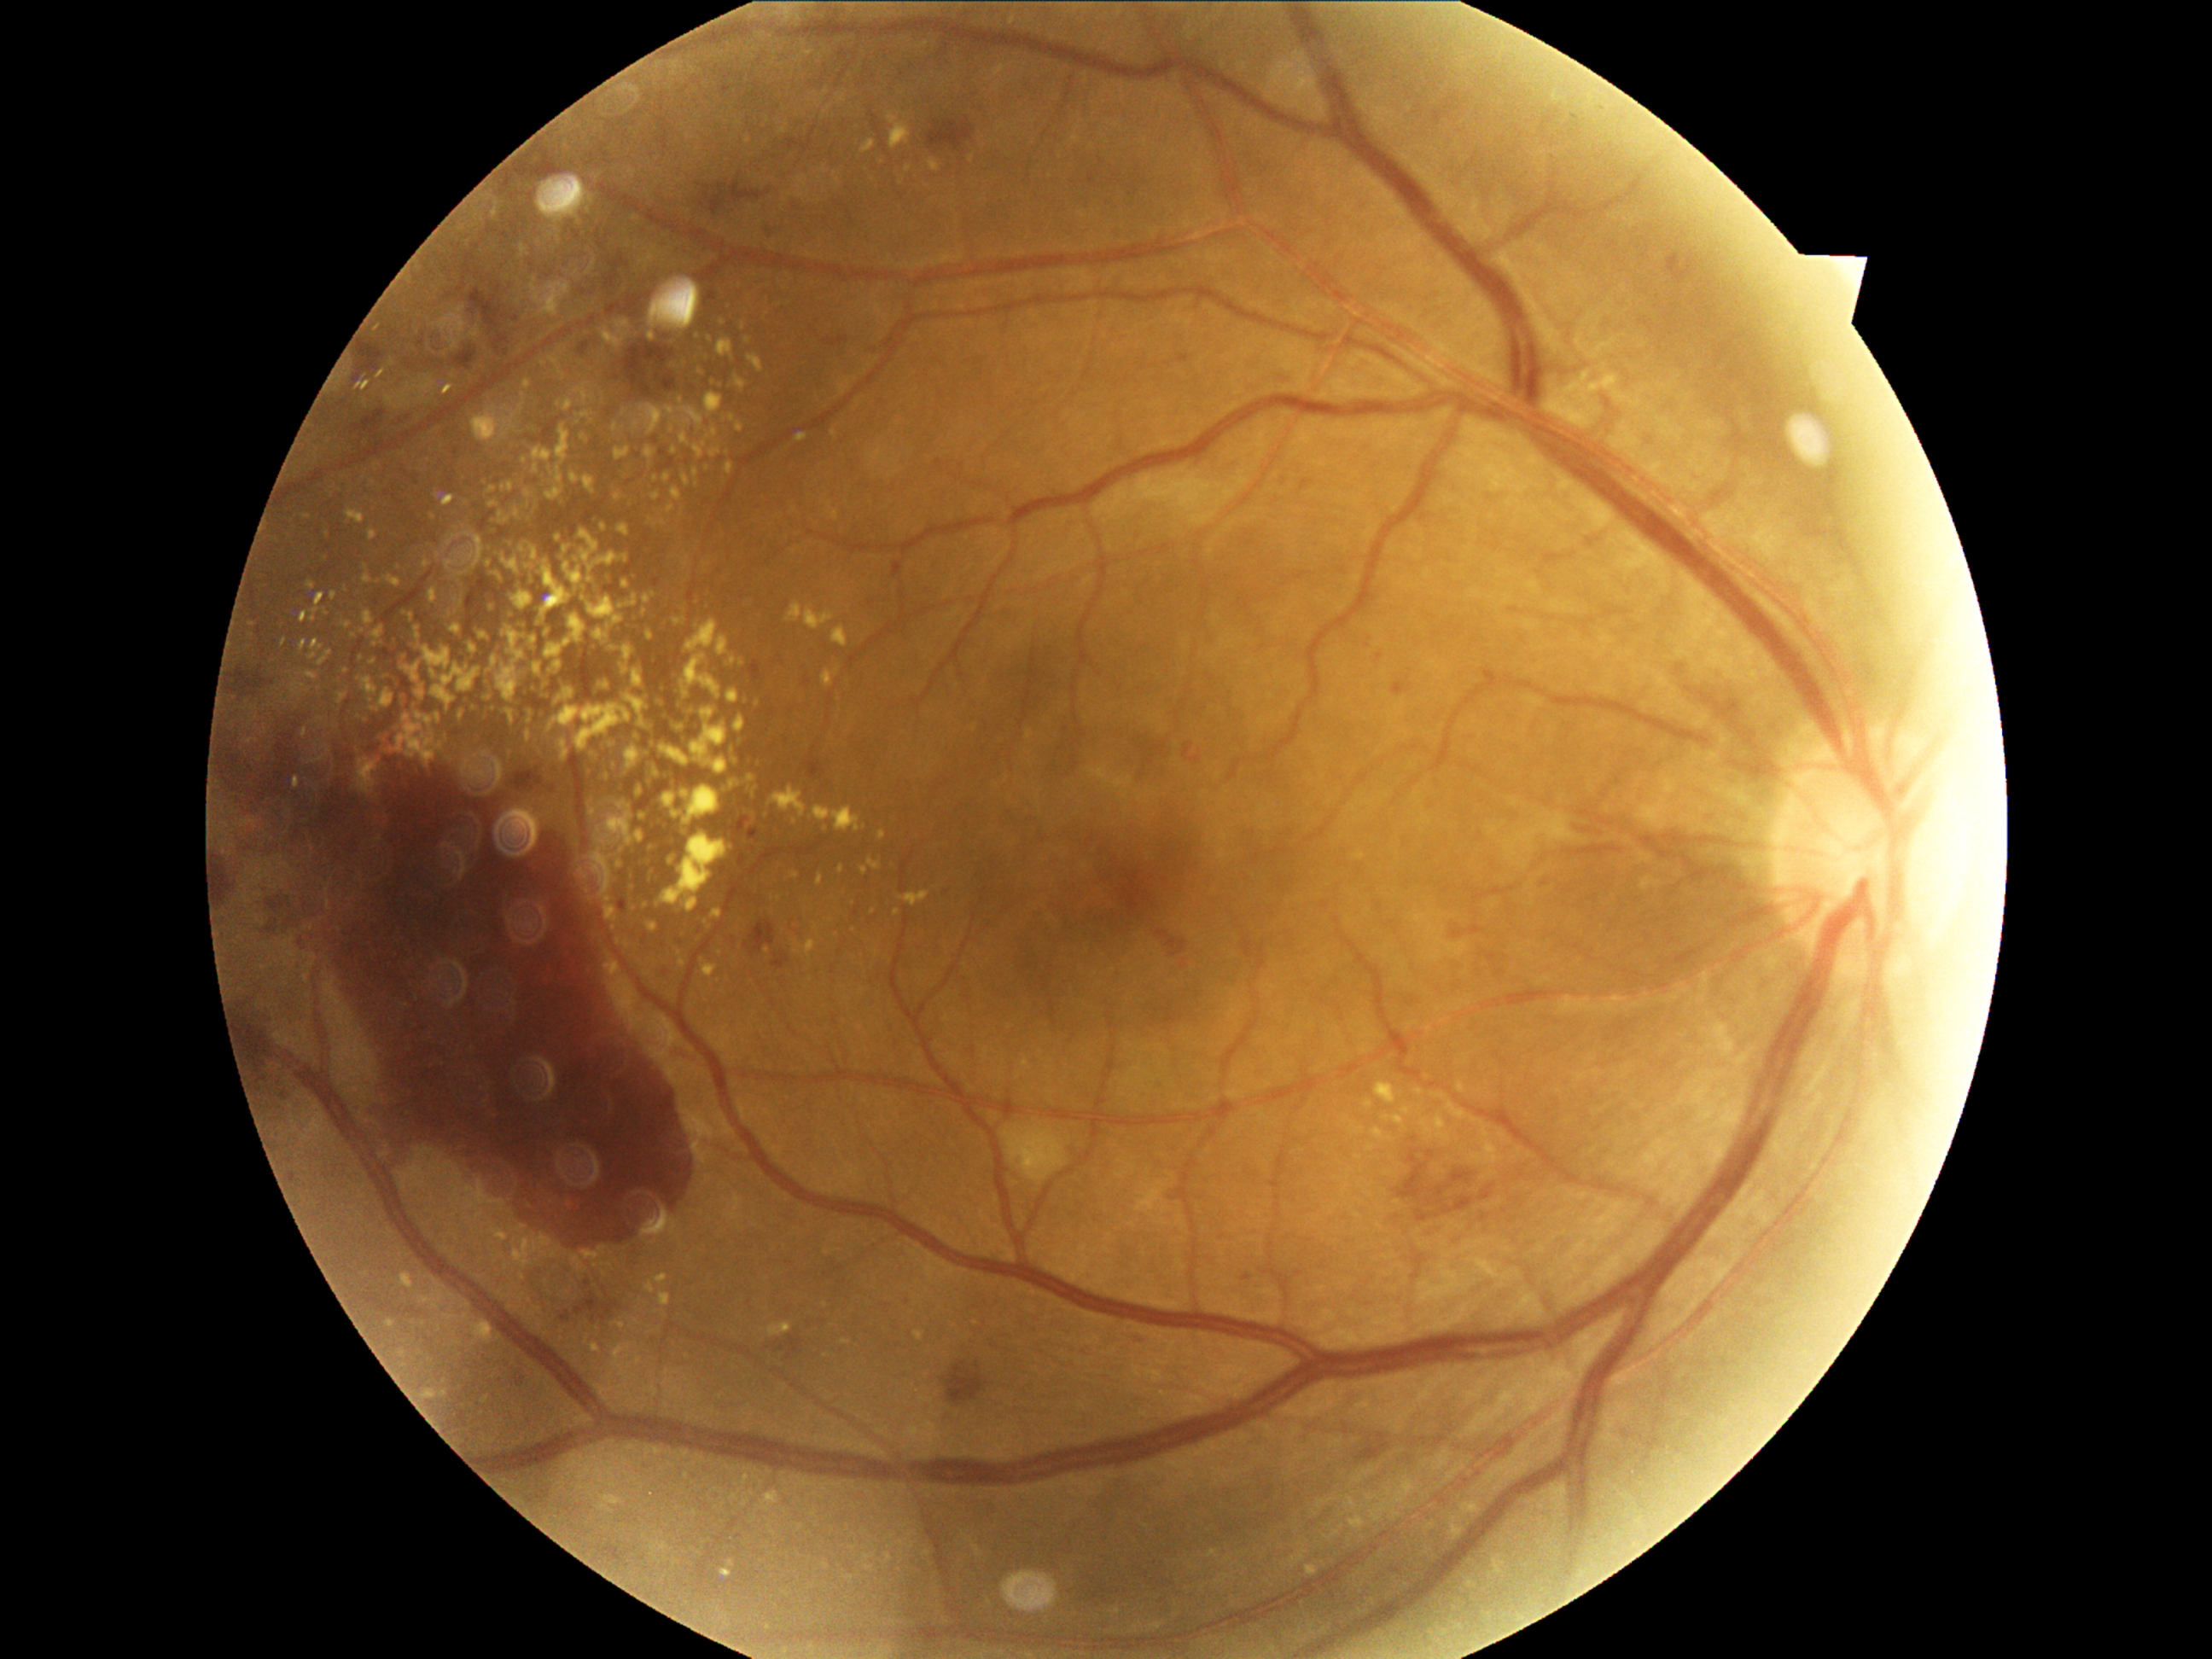
{"partial":true,"dr_grade":4,"dr_grade_name":"PDR","lesions":{"he":[[1361,1445,1388,1460],[457,346,477,370],[469,284,504,334],[361,346,381,371],[494,334,509,352],[351,728,393,755],[624,342,675,399],[774,1344,786,1351],[788,1334,803,1359],[1481,1185,1494,1201],[750,923,776,955],[1156,931,1187,957],[240,1006,269,1080],[1397,1151,1428,1201],[221,863,240,899]],"he_small":[[1428,1202],[708,187],[1429,1154],[769,191]],"ex":[[416,626,421,641],[549,706,632,752],[501,556,521,586],[492,649,501,655],[475,1322,492,1342],[605,905,619,923],[498,661,508,668],[736,424,743,433],[400,653,409,665],[402,1274,414,1288],[492,532,501,538],[636,784,646,798]],"ex_small":[[543,690],[663,722],[395,682],[1406,1111],[308,516],[505,424],[529,506]],"ma":[[289,1172,301,1182],[894,562,904,578],[680,936,689,945],[1167,1185,1179,1201],[405,479,417,484],[269,678,274,694],[1175,358,1185,363],[706,291,718,303],[1068,1148,1076,1160],[748,829,760,842],[738,851,747,870],[902,1296,911,1307],[808,762,825,777],[697,929,707,941]],"ma_small":[[740,845],[1195,760],[283,1095]]}}